45-degree field of view.
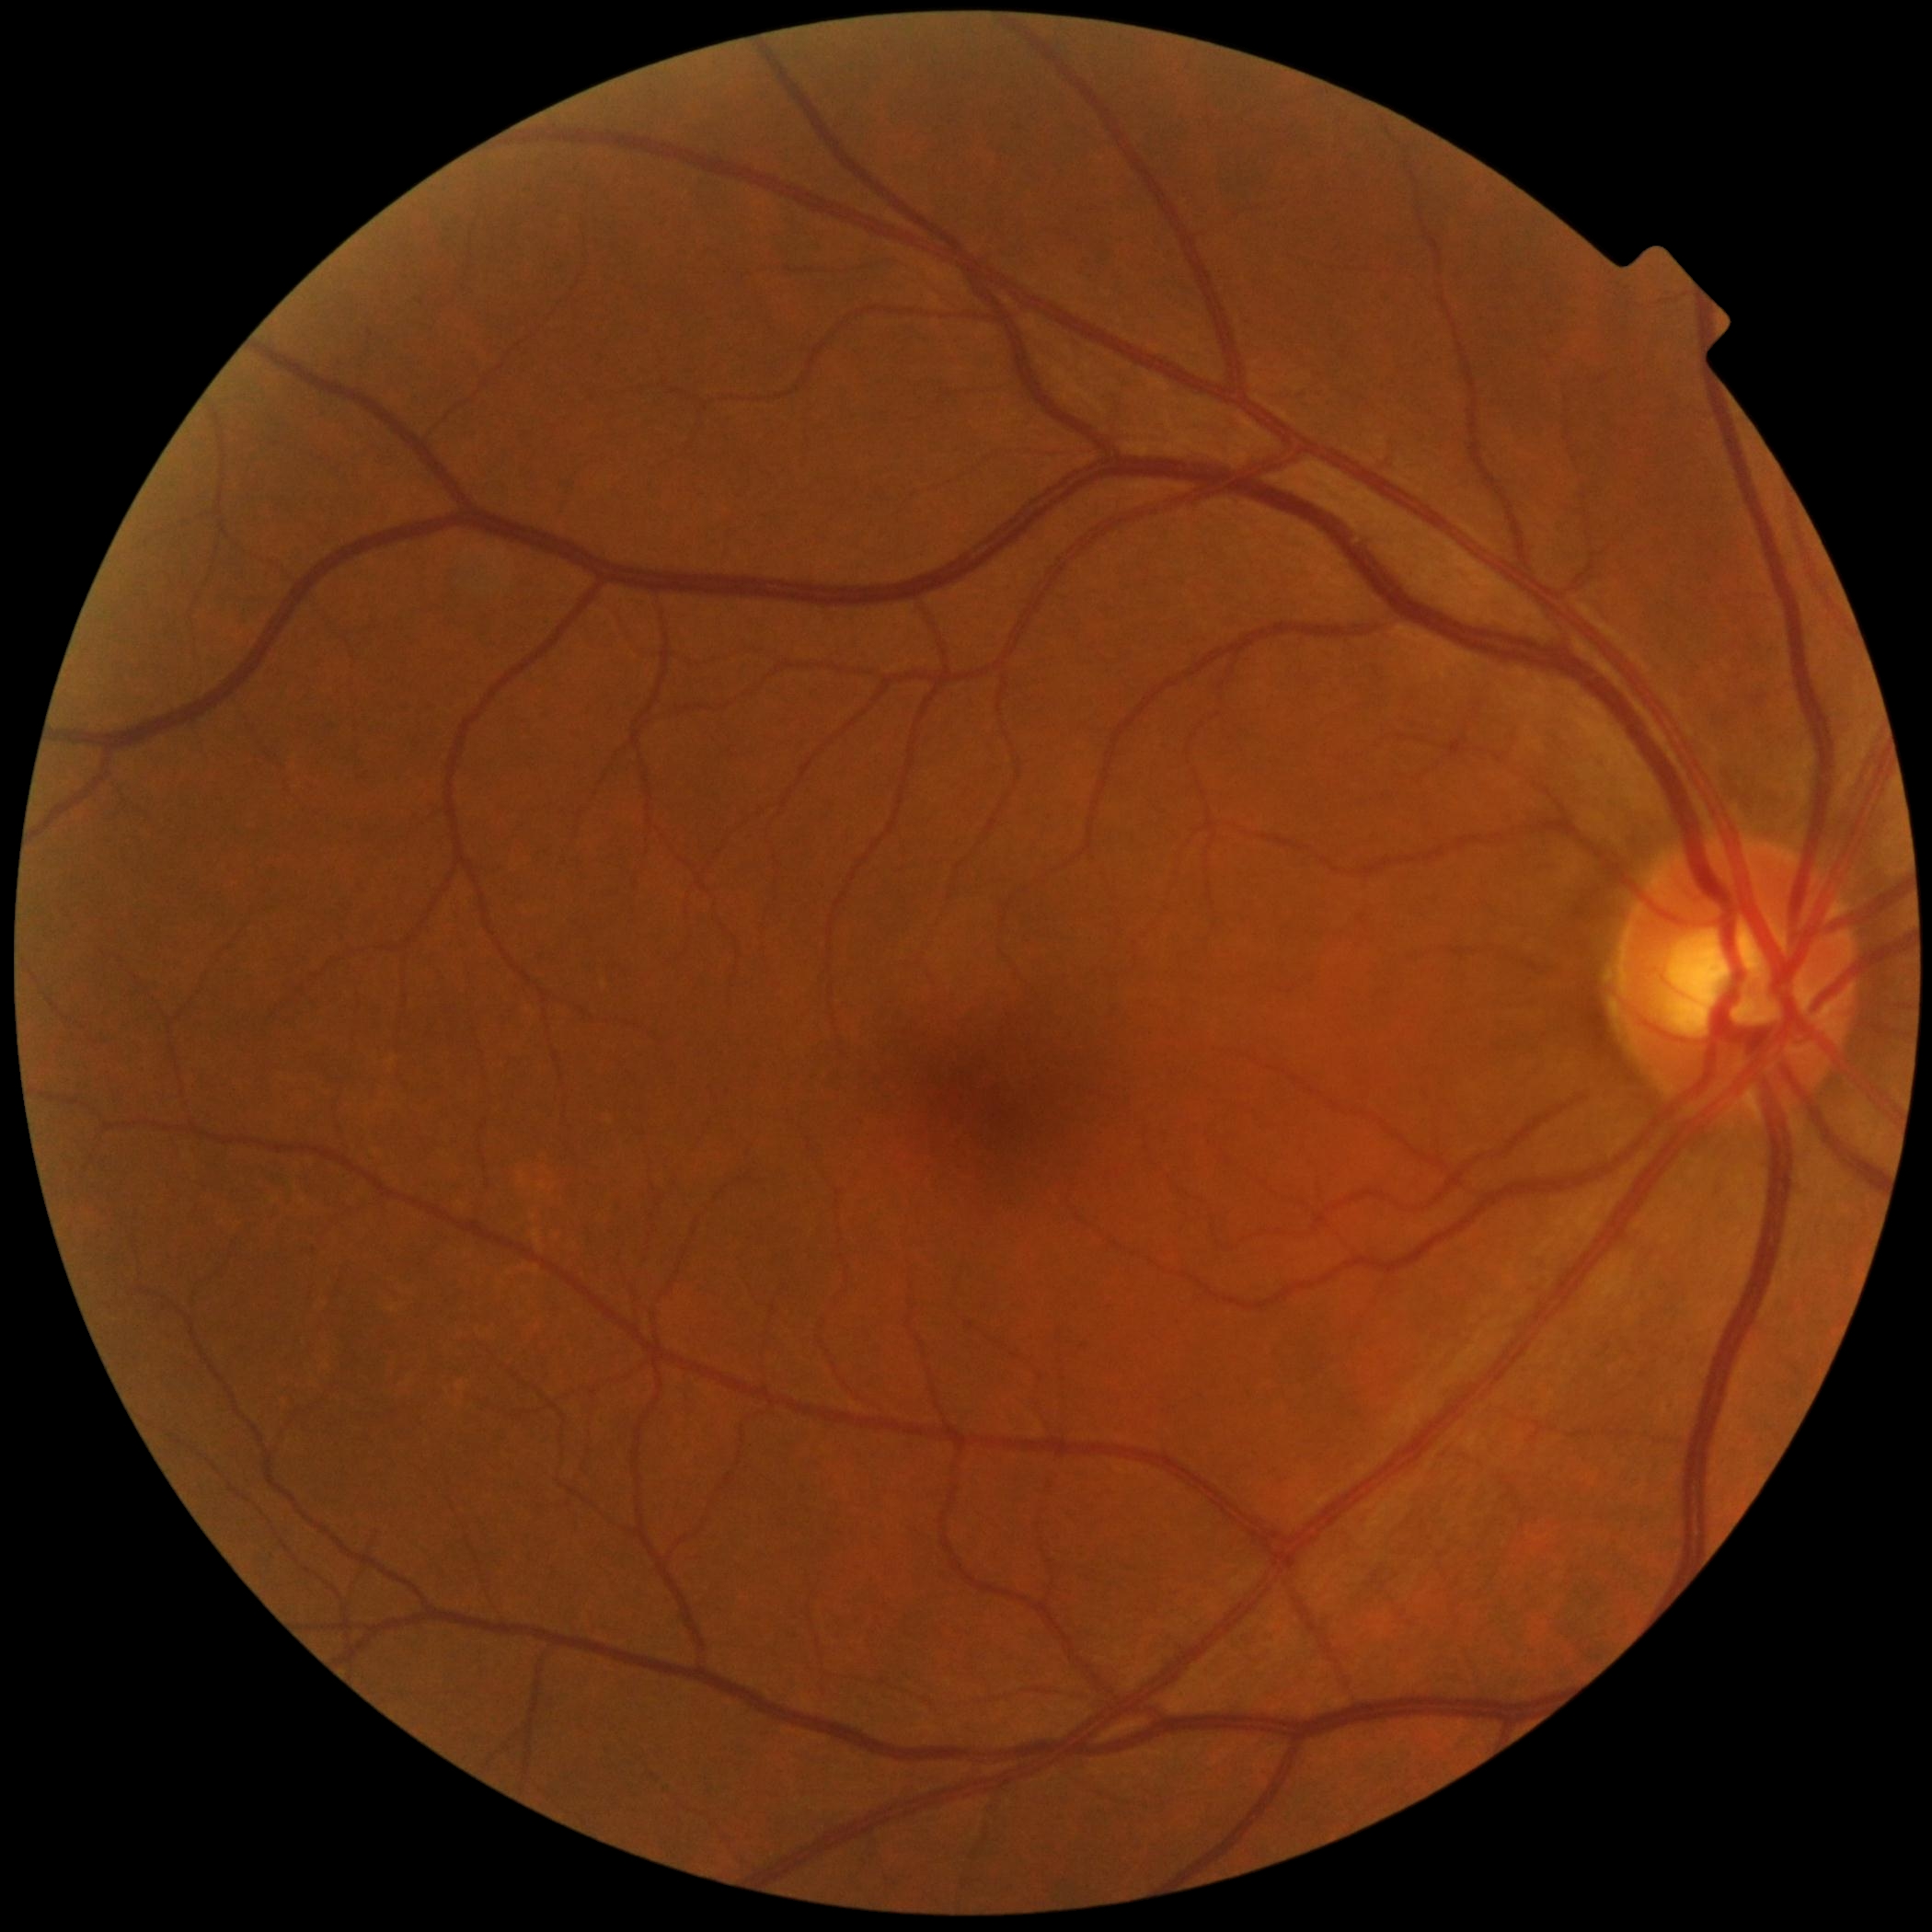 Diabetic retinopathy severity is no apparent diabetic retinopathy (grade 0).